45° field of view, retinal fundus photograph, image size 2352x1568 — 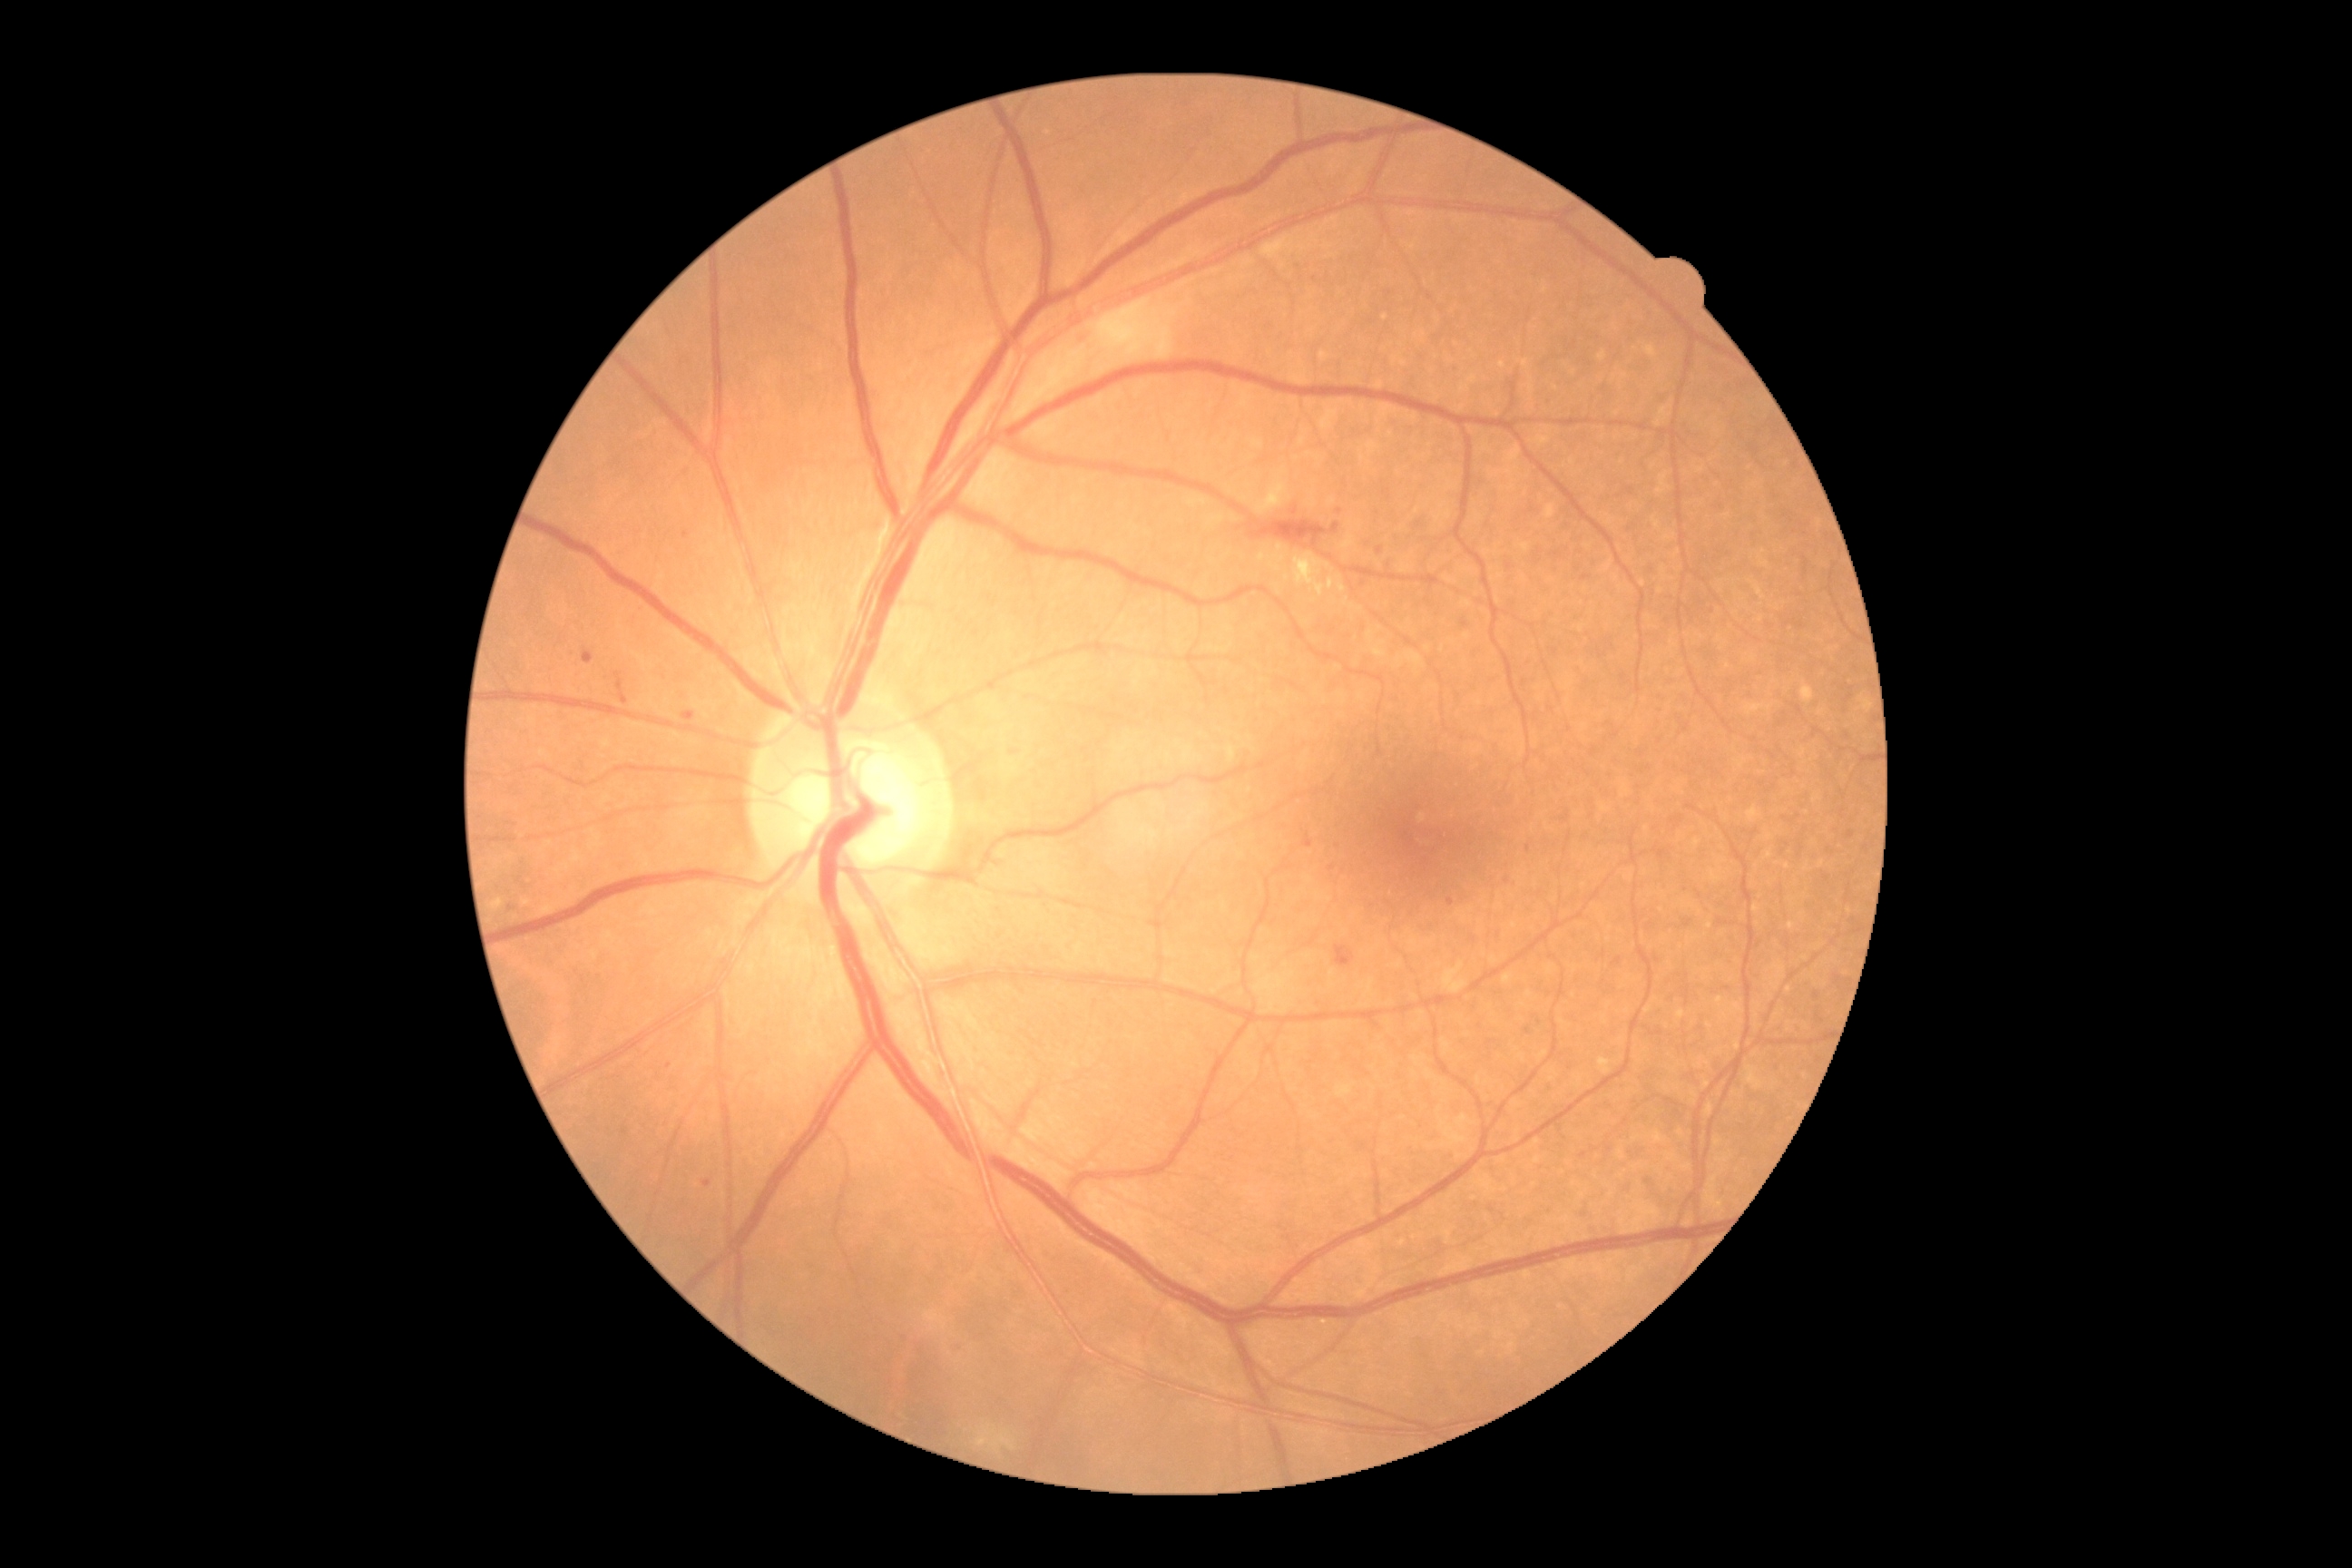

DR stage is 2.